Davis DR grading:
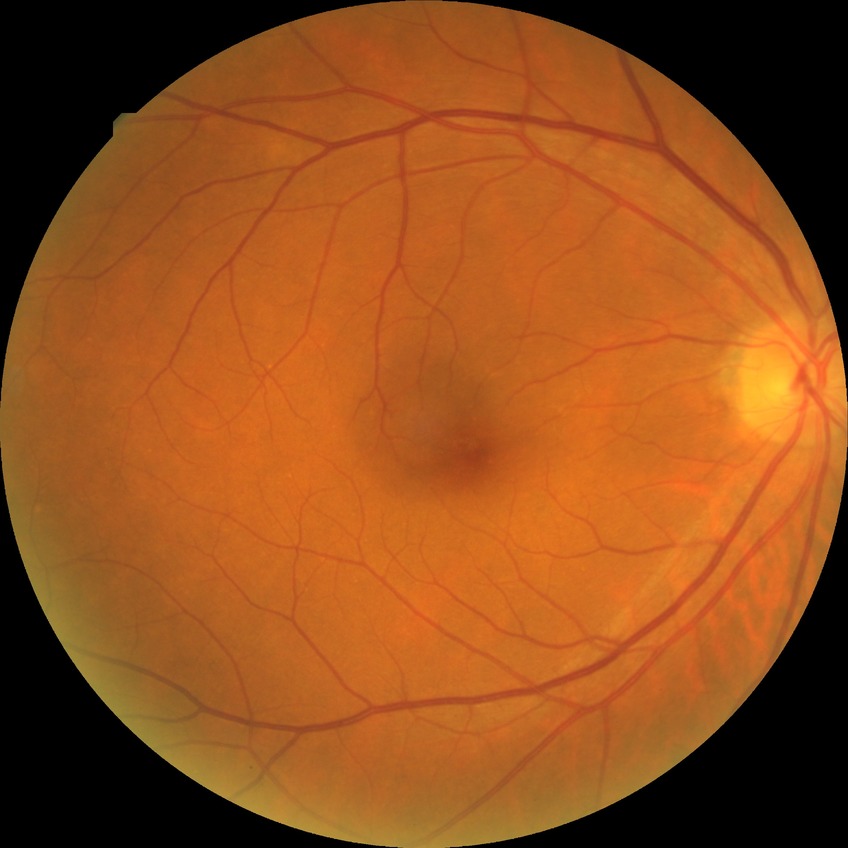
No apparent diabetic retinopathy. Modified Davis grade is NDR.